Infant wide-field fundus photograph · captured with the Natus RetCam Envision (130° field of view).
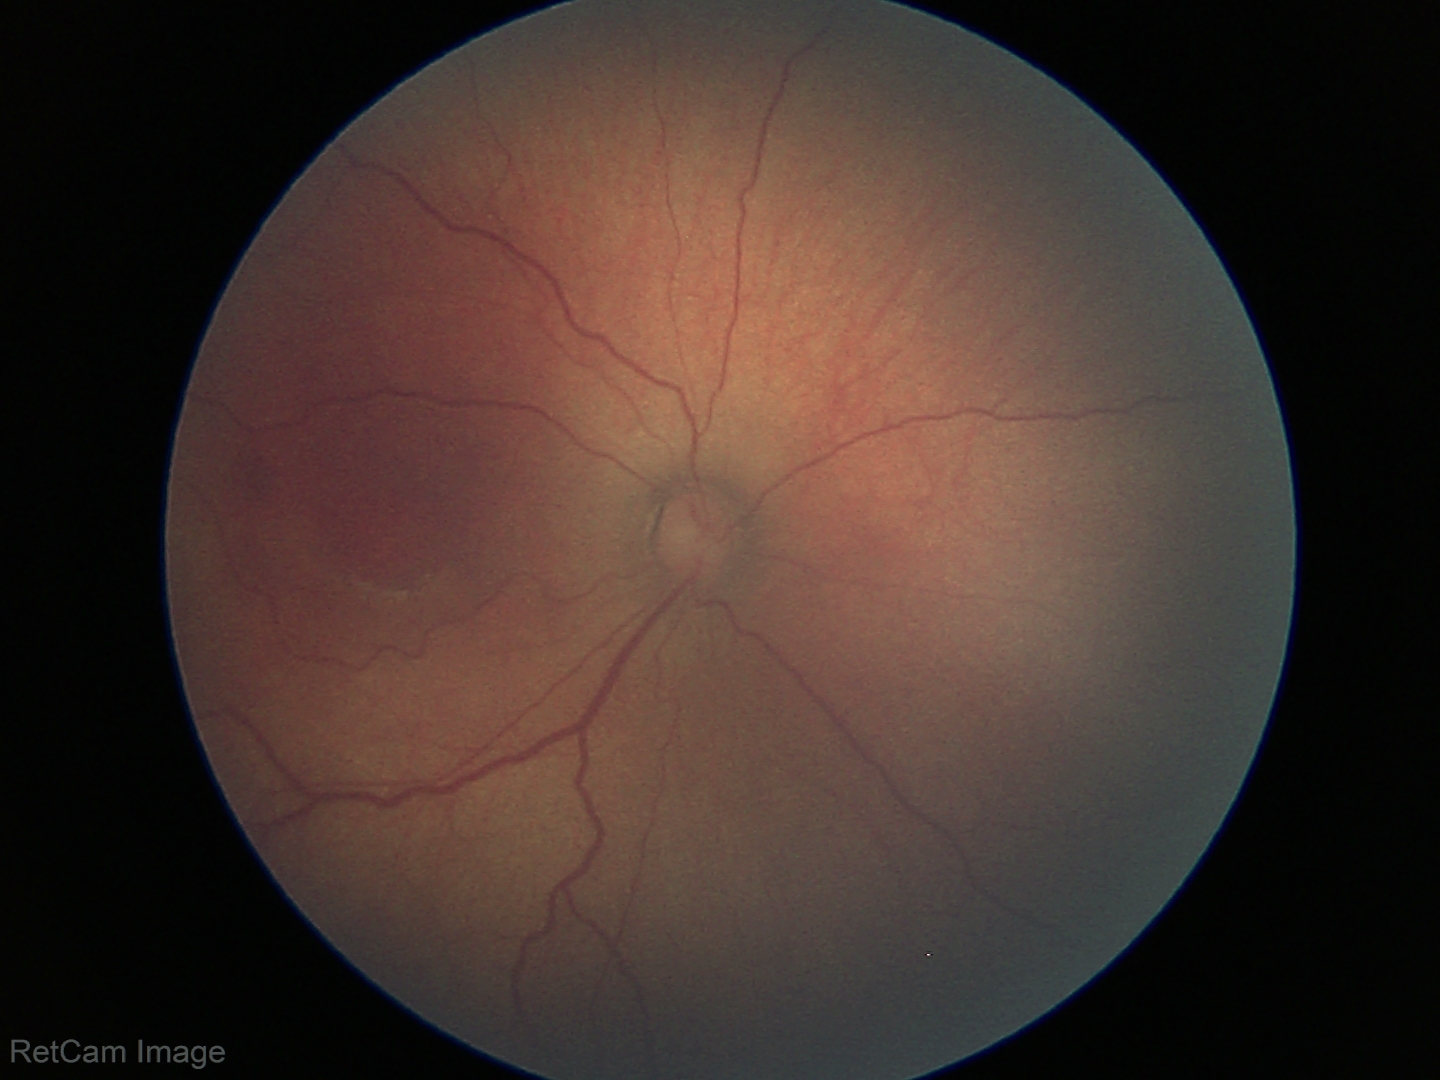 Screening series with retinopathy of prematurity (ROP) stage 2.